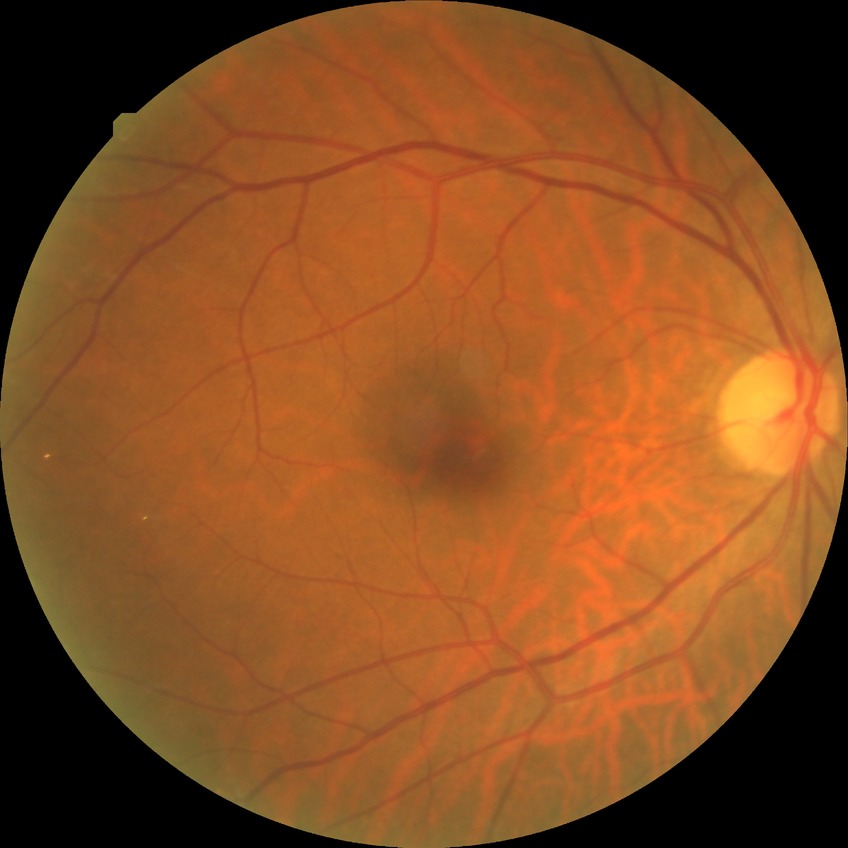
{
  "davis_grade": "no diabetic retinopathy"
}